Color fundus photograph. 1960 by 1897 pixels:
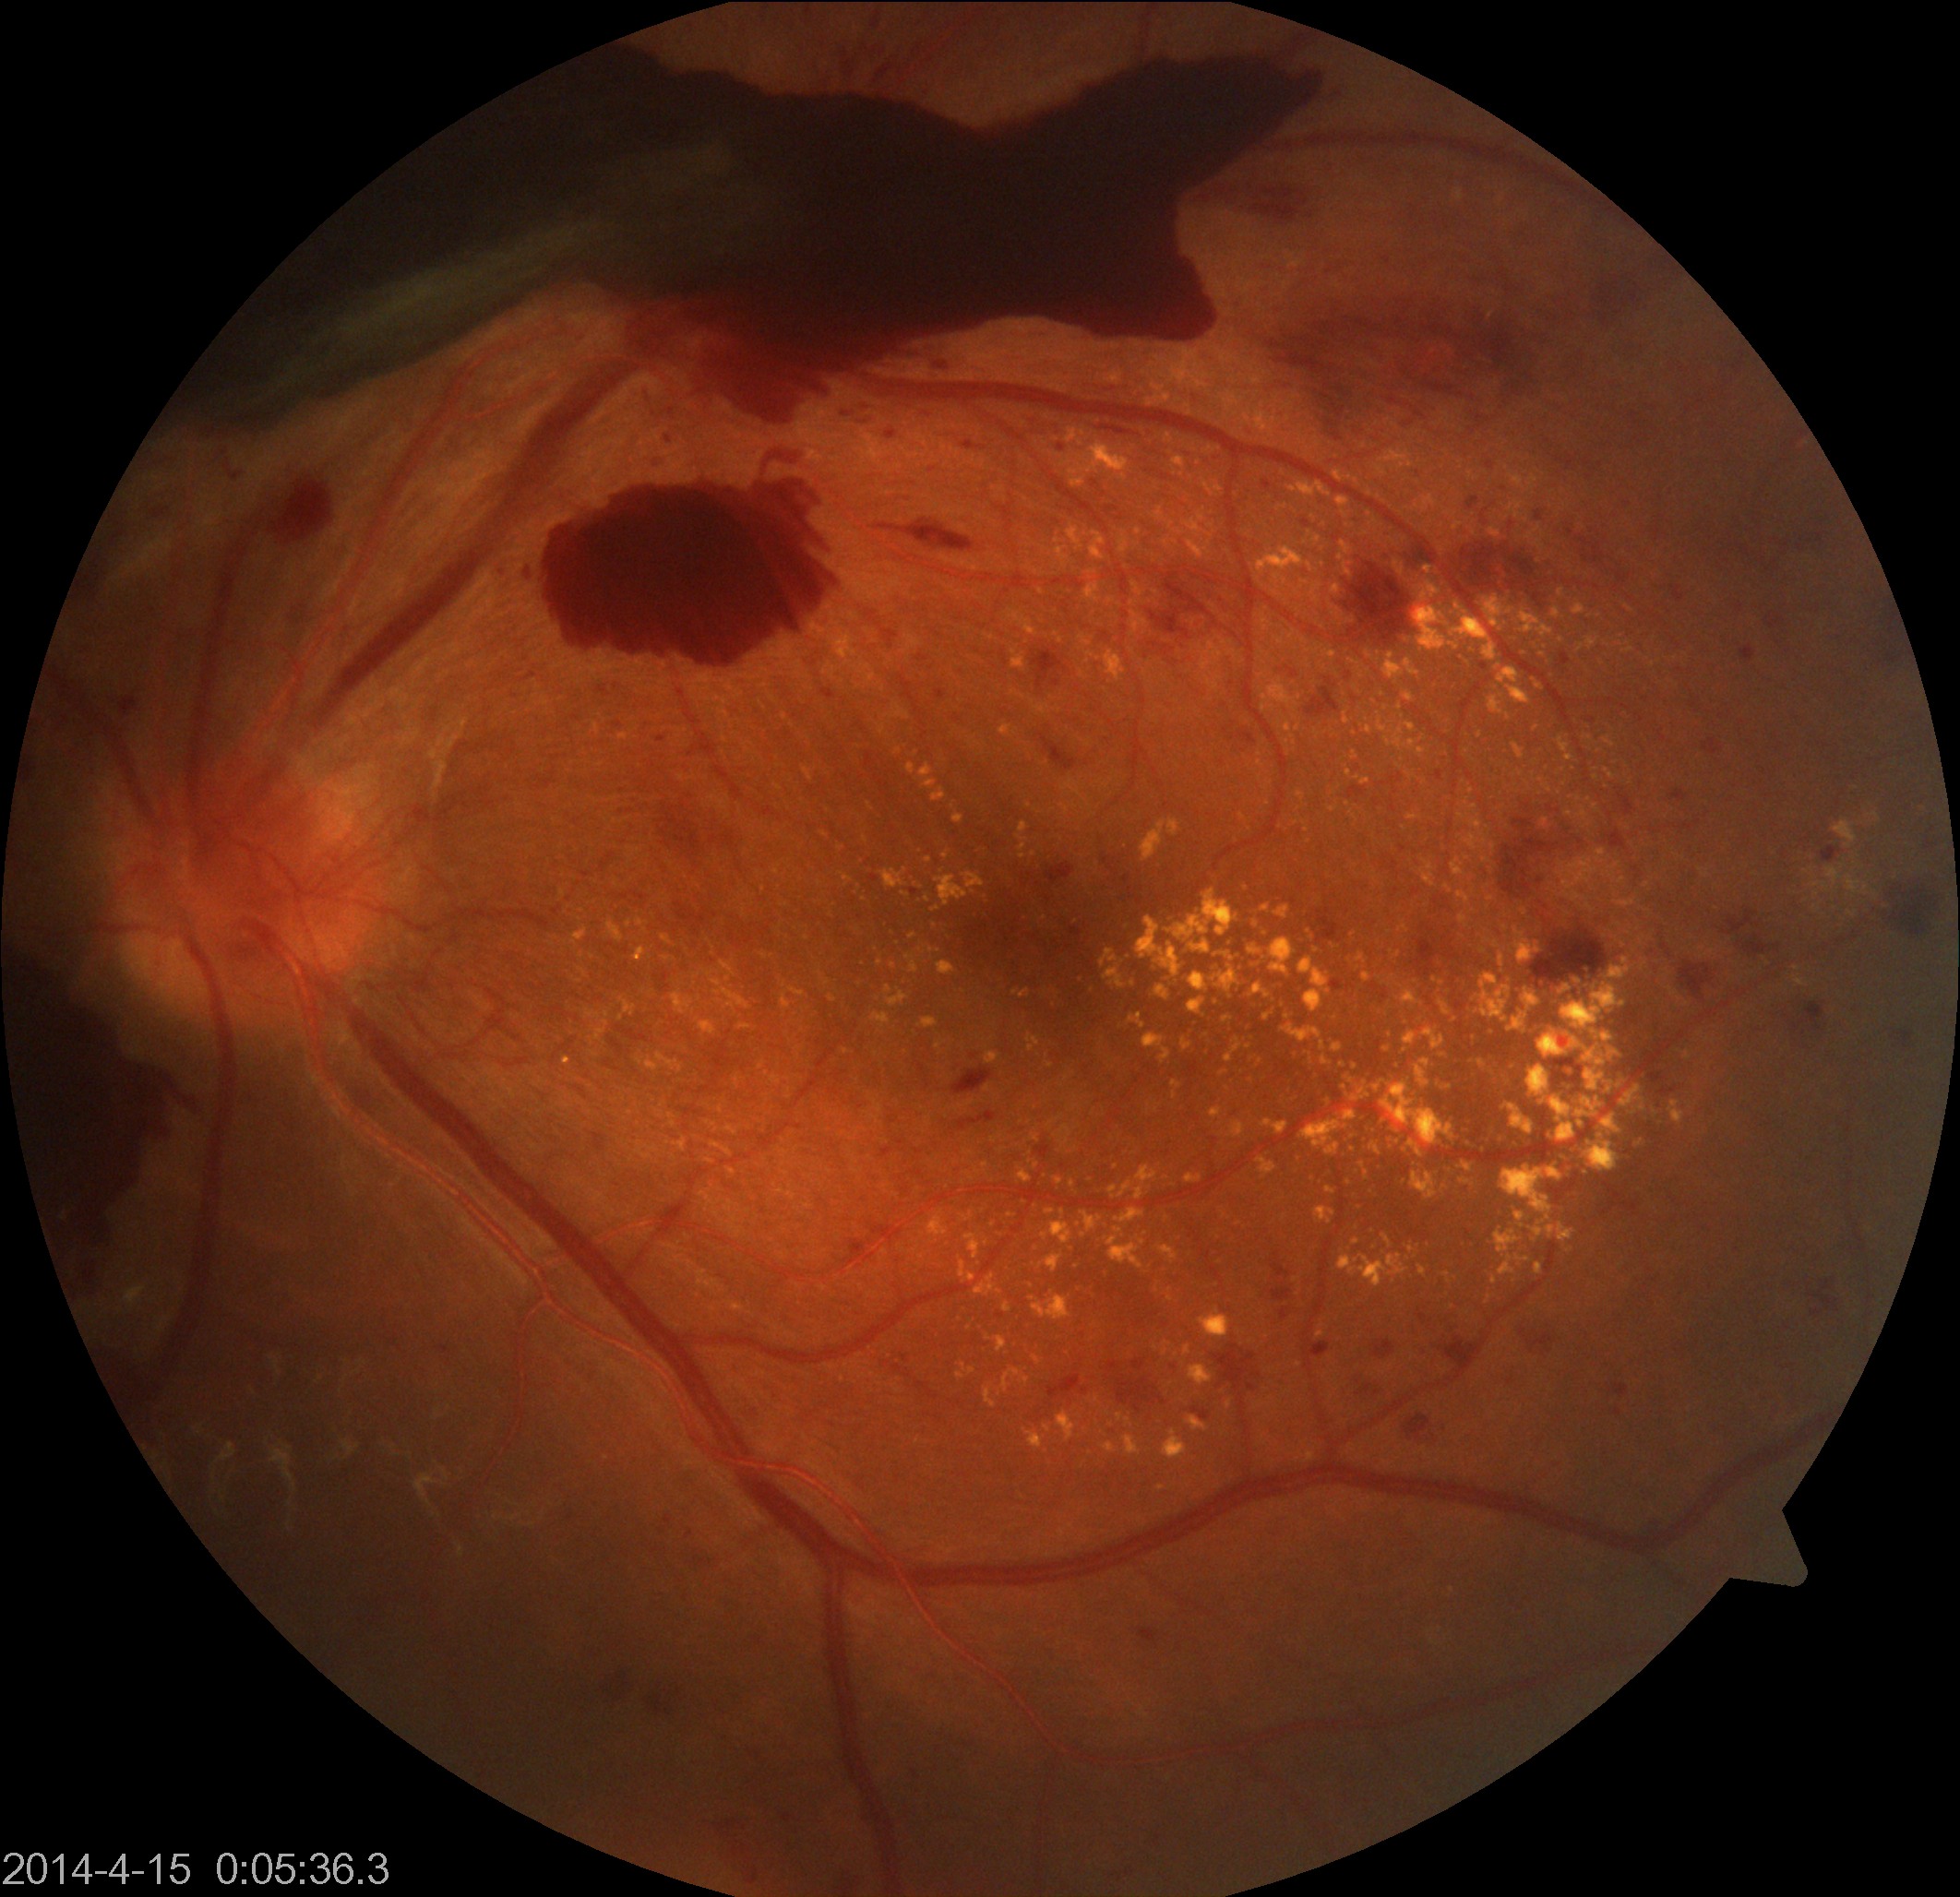 Diagnosis: severe non-proliferative or proliferative diabetic retinopathy.